50-degree field of view:
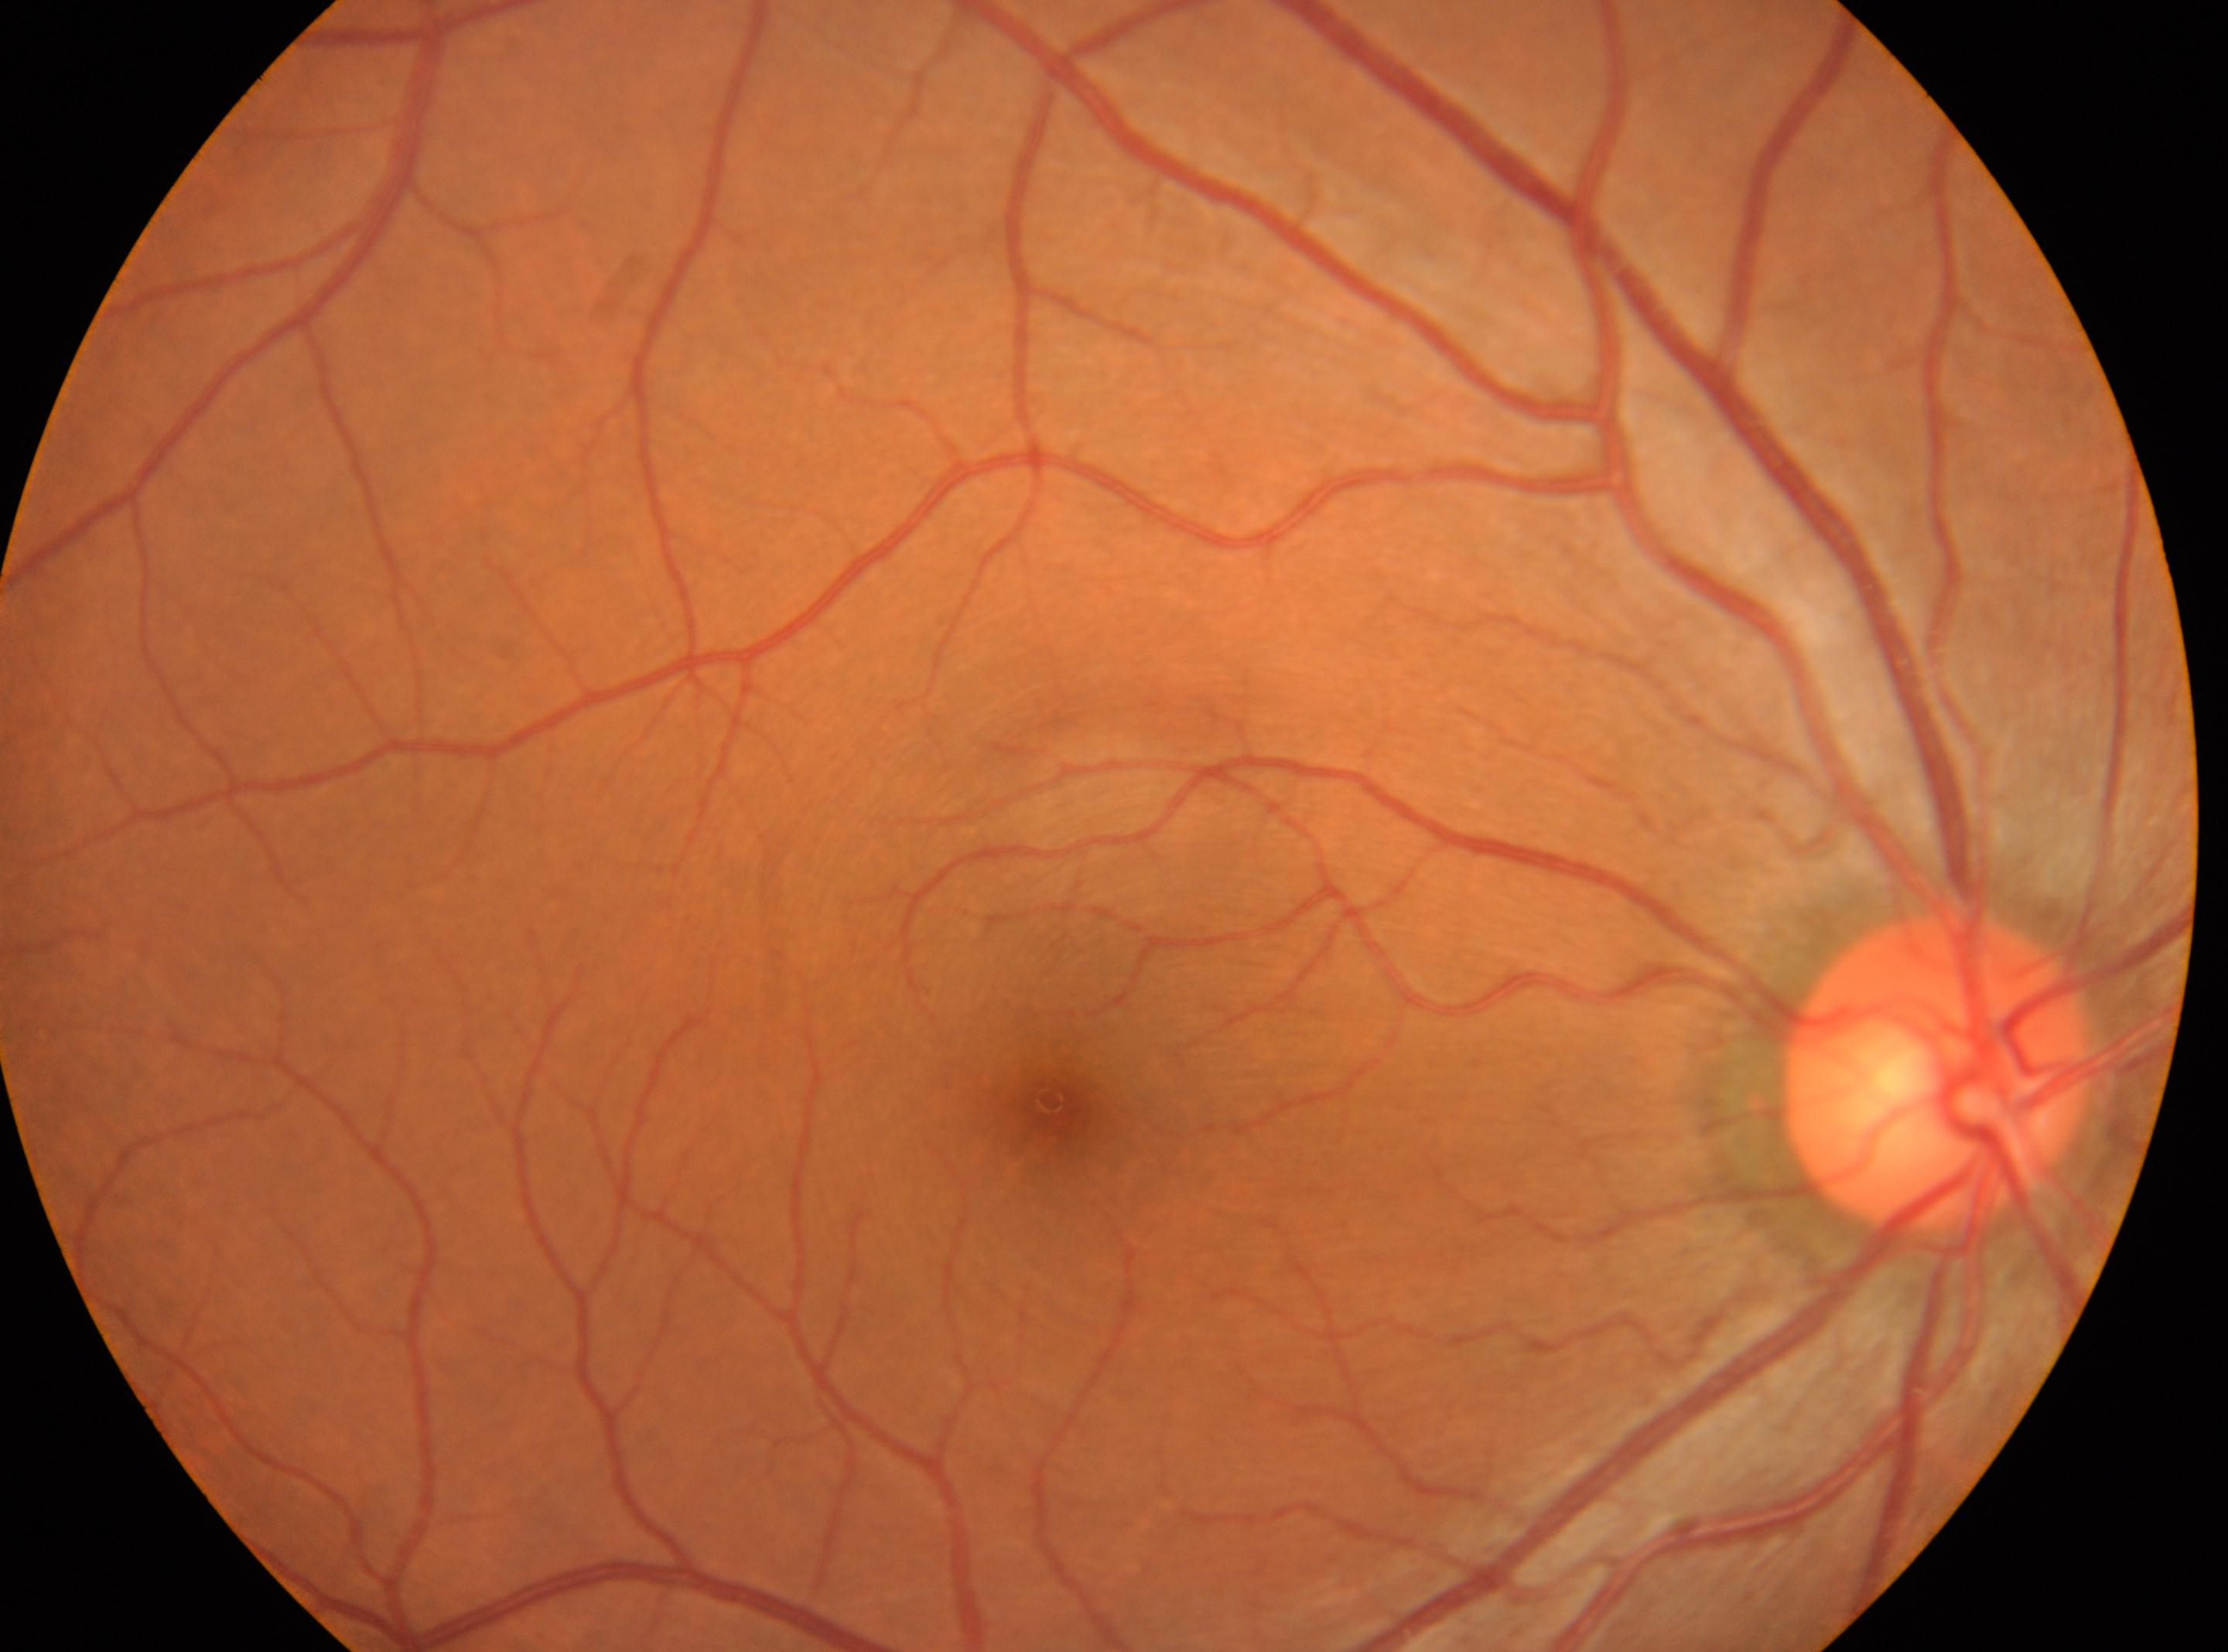 | field | value |
|---|---|
| the fovea | (1055, 1109) |
| ONH | (1939, 1072) |
| eye | OD |
| DR | grade 0 (no apparent retinopathy) |